2102 by 1736 pixels · fundus photo — 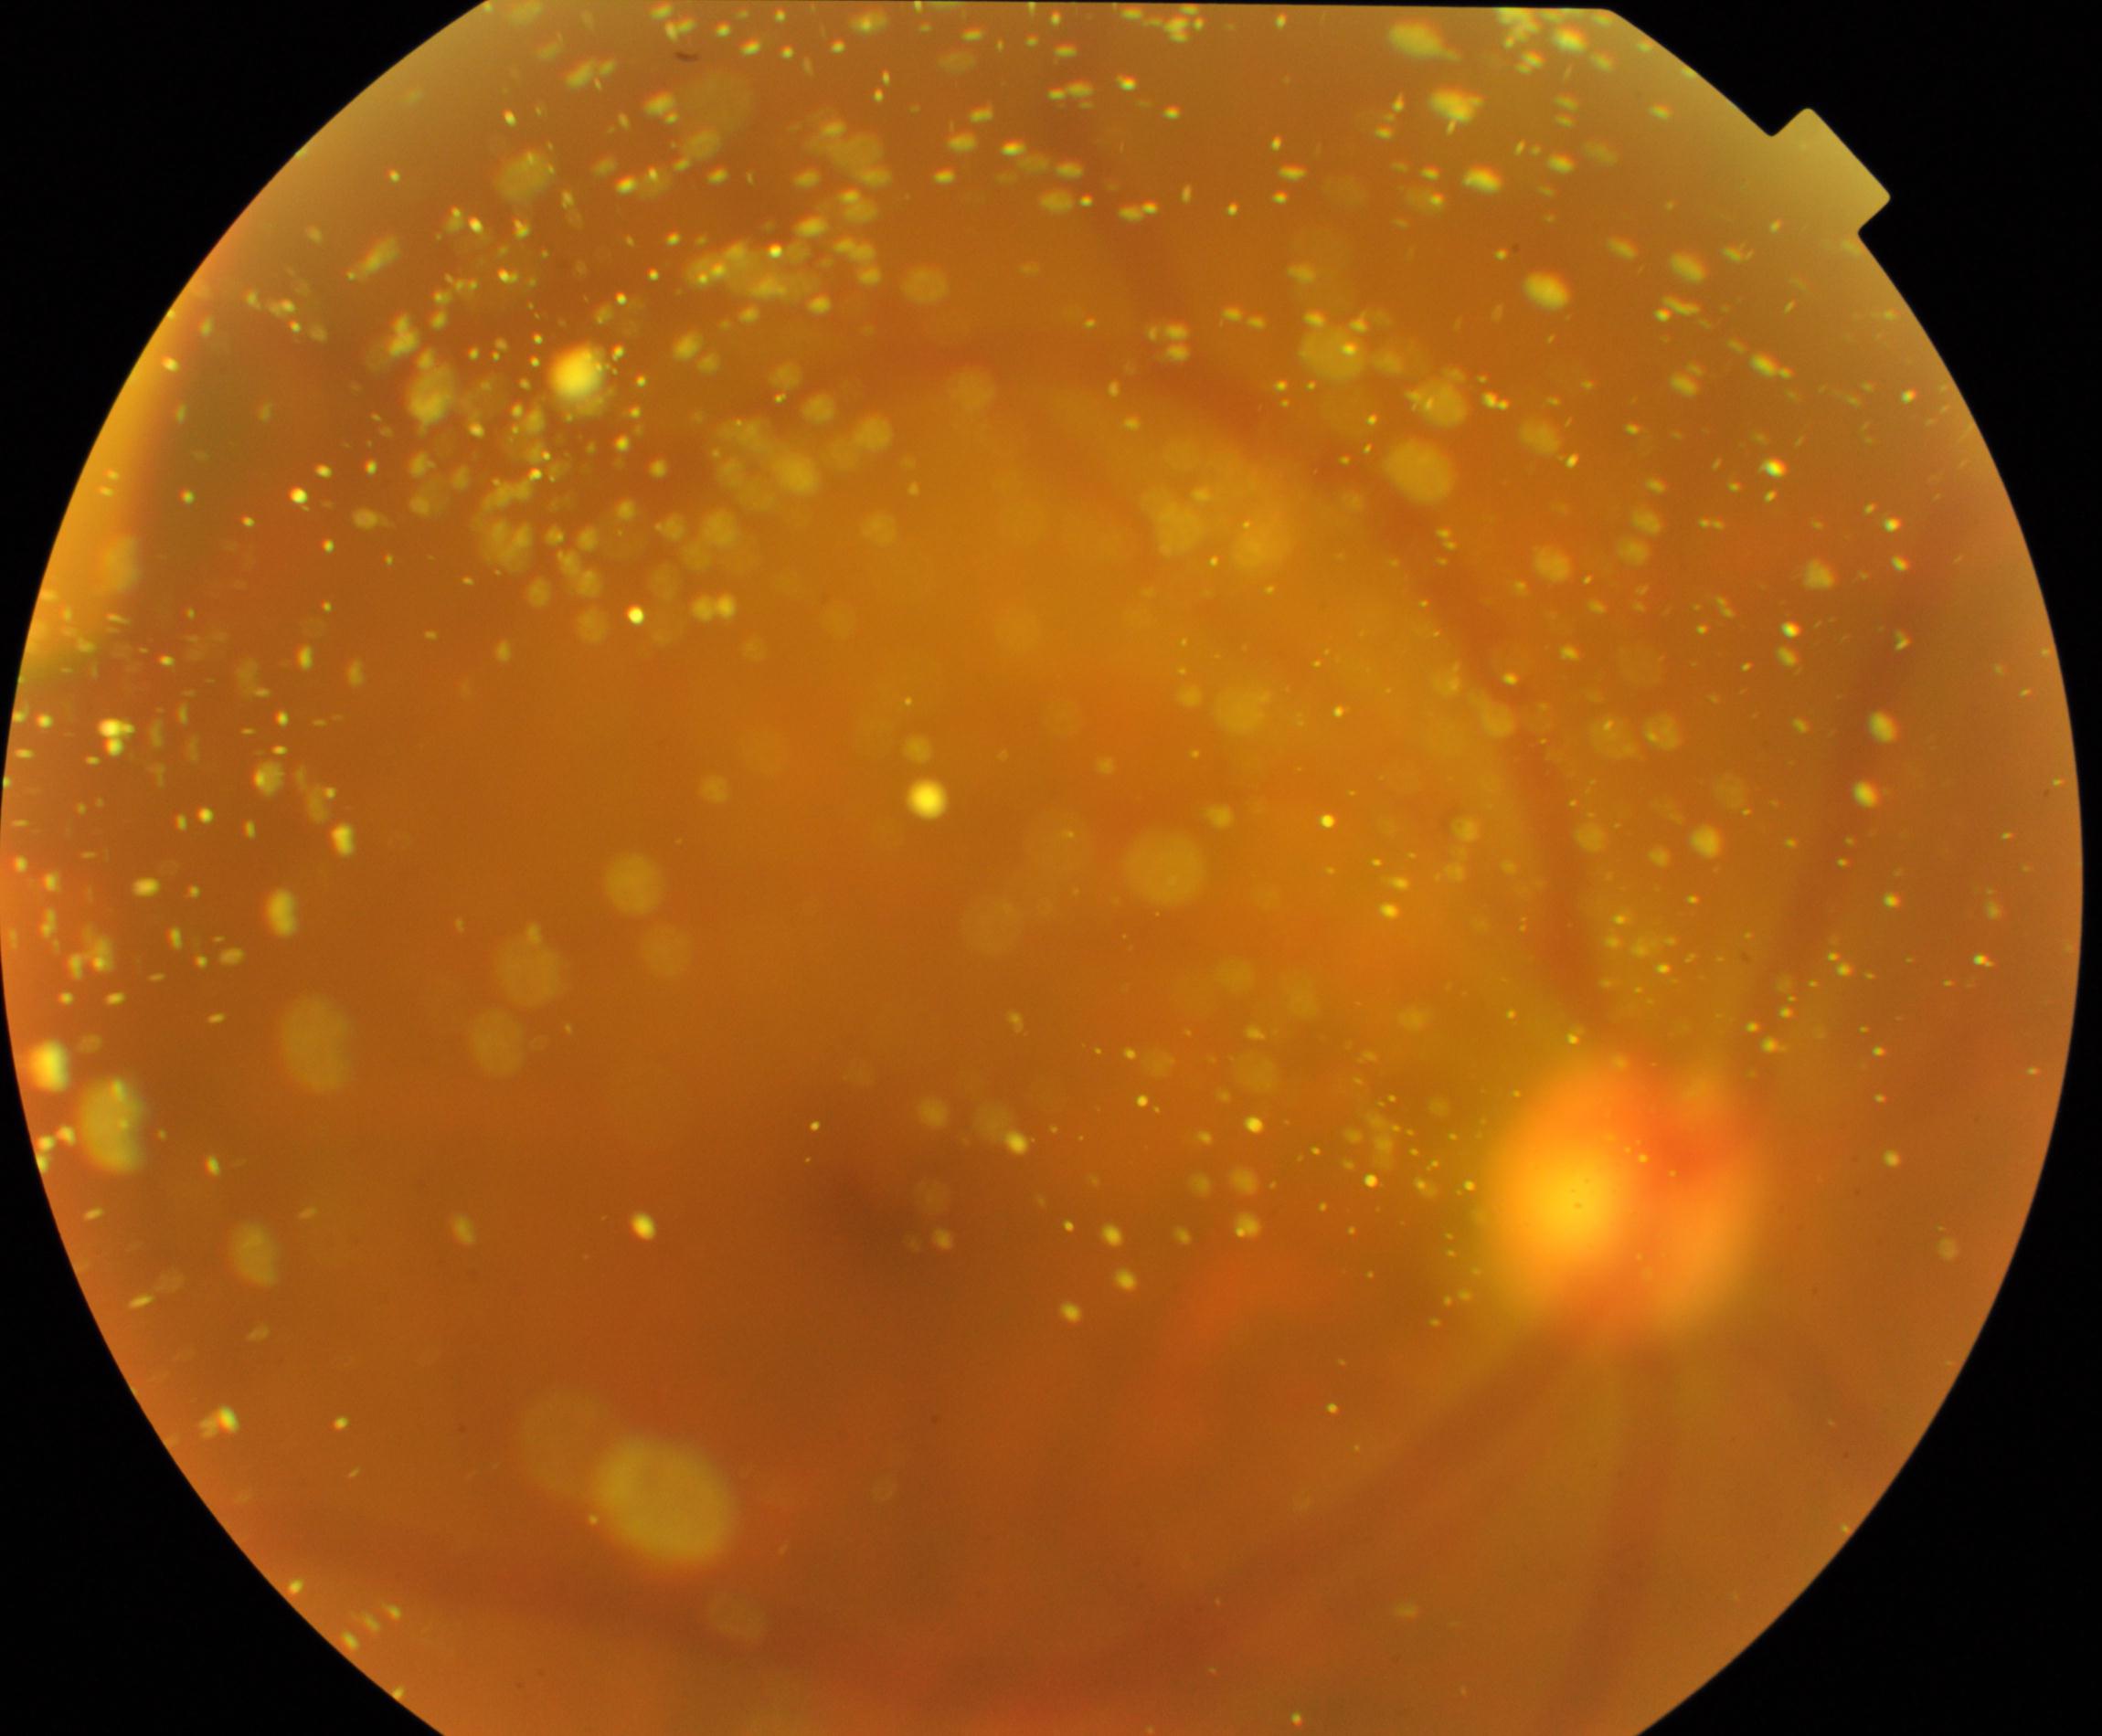
Impression: vitreous particles.